848x848 — 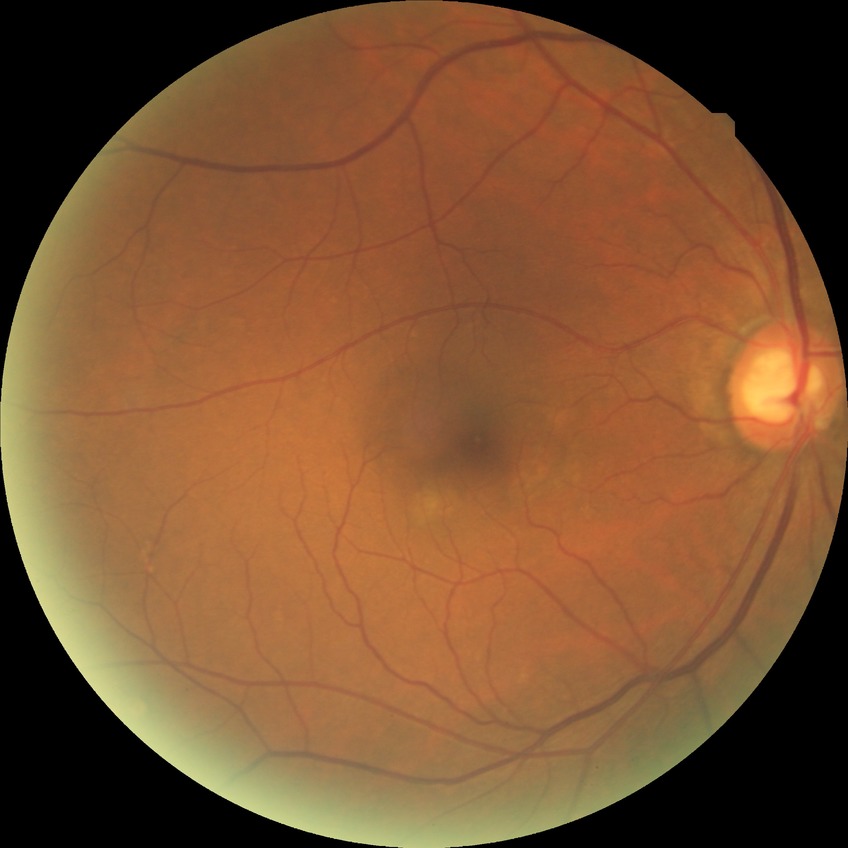
Diabetic retinopathy stage: no diabetic retinopathy.